45° FOV
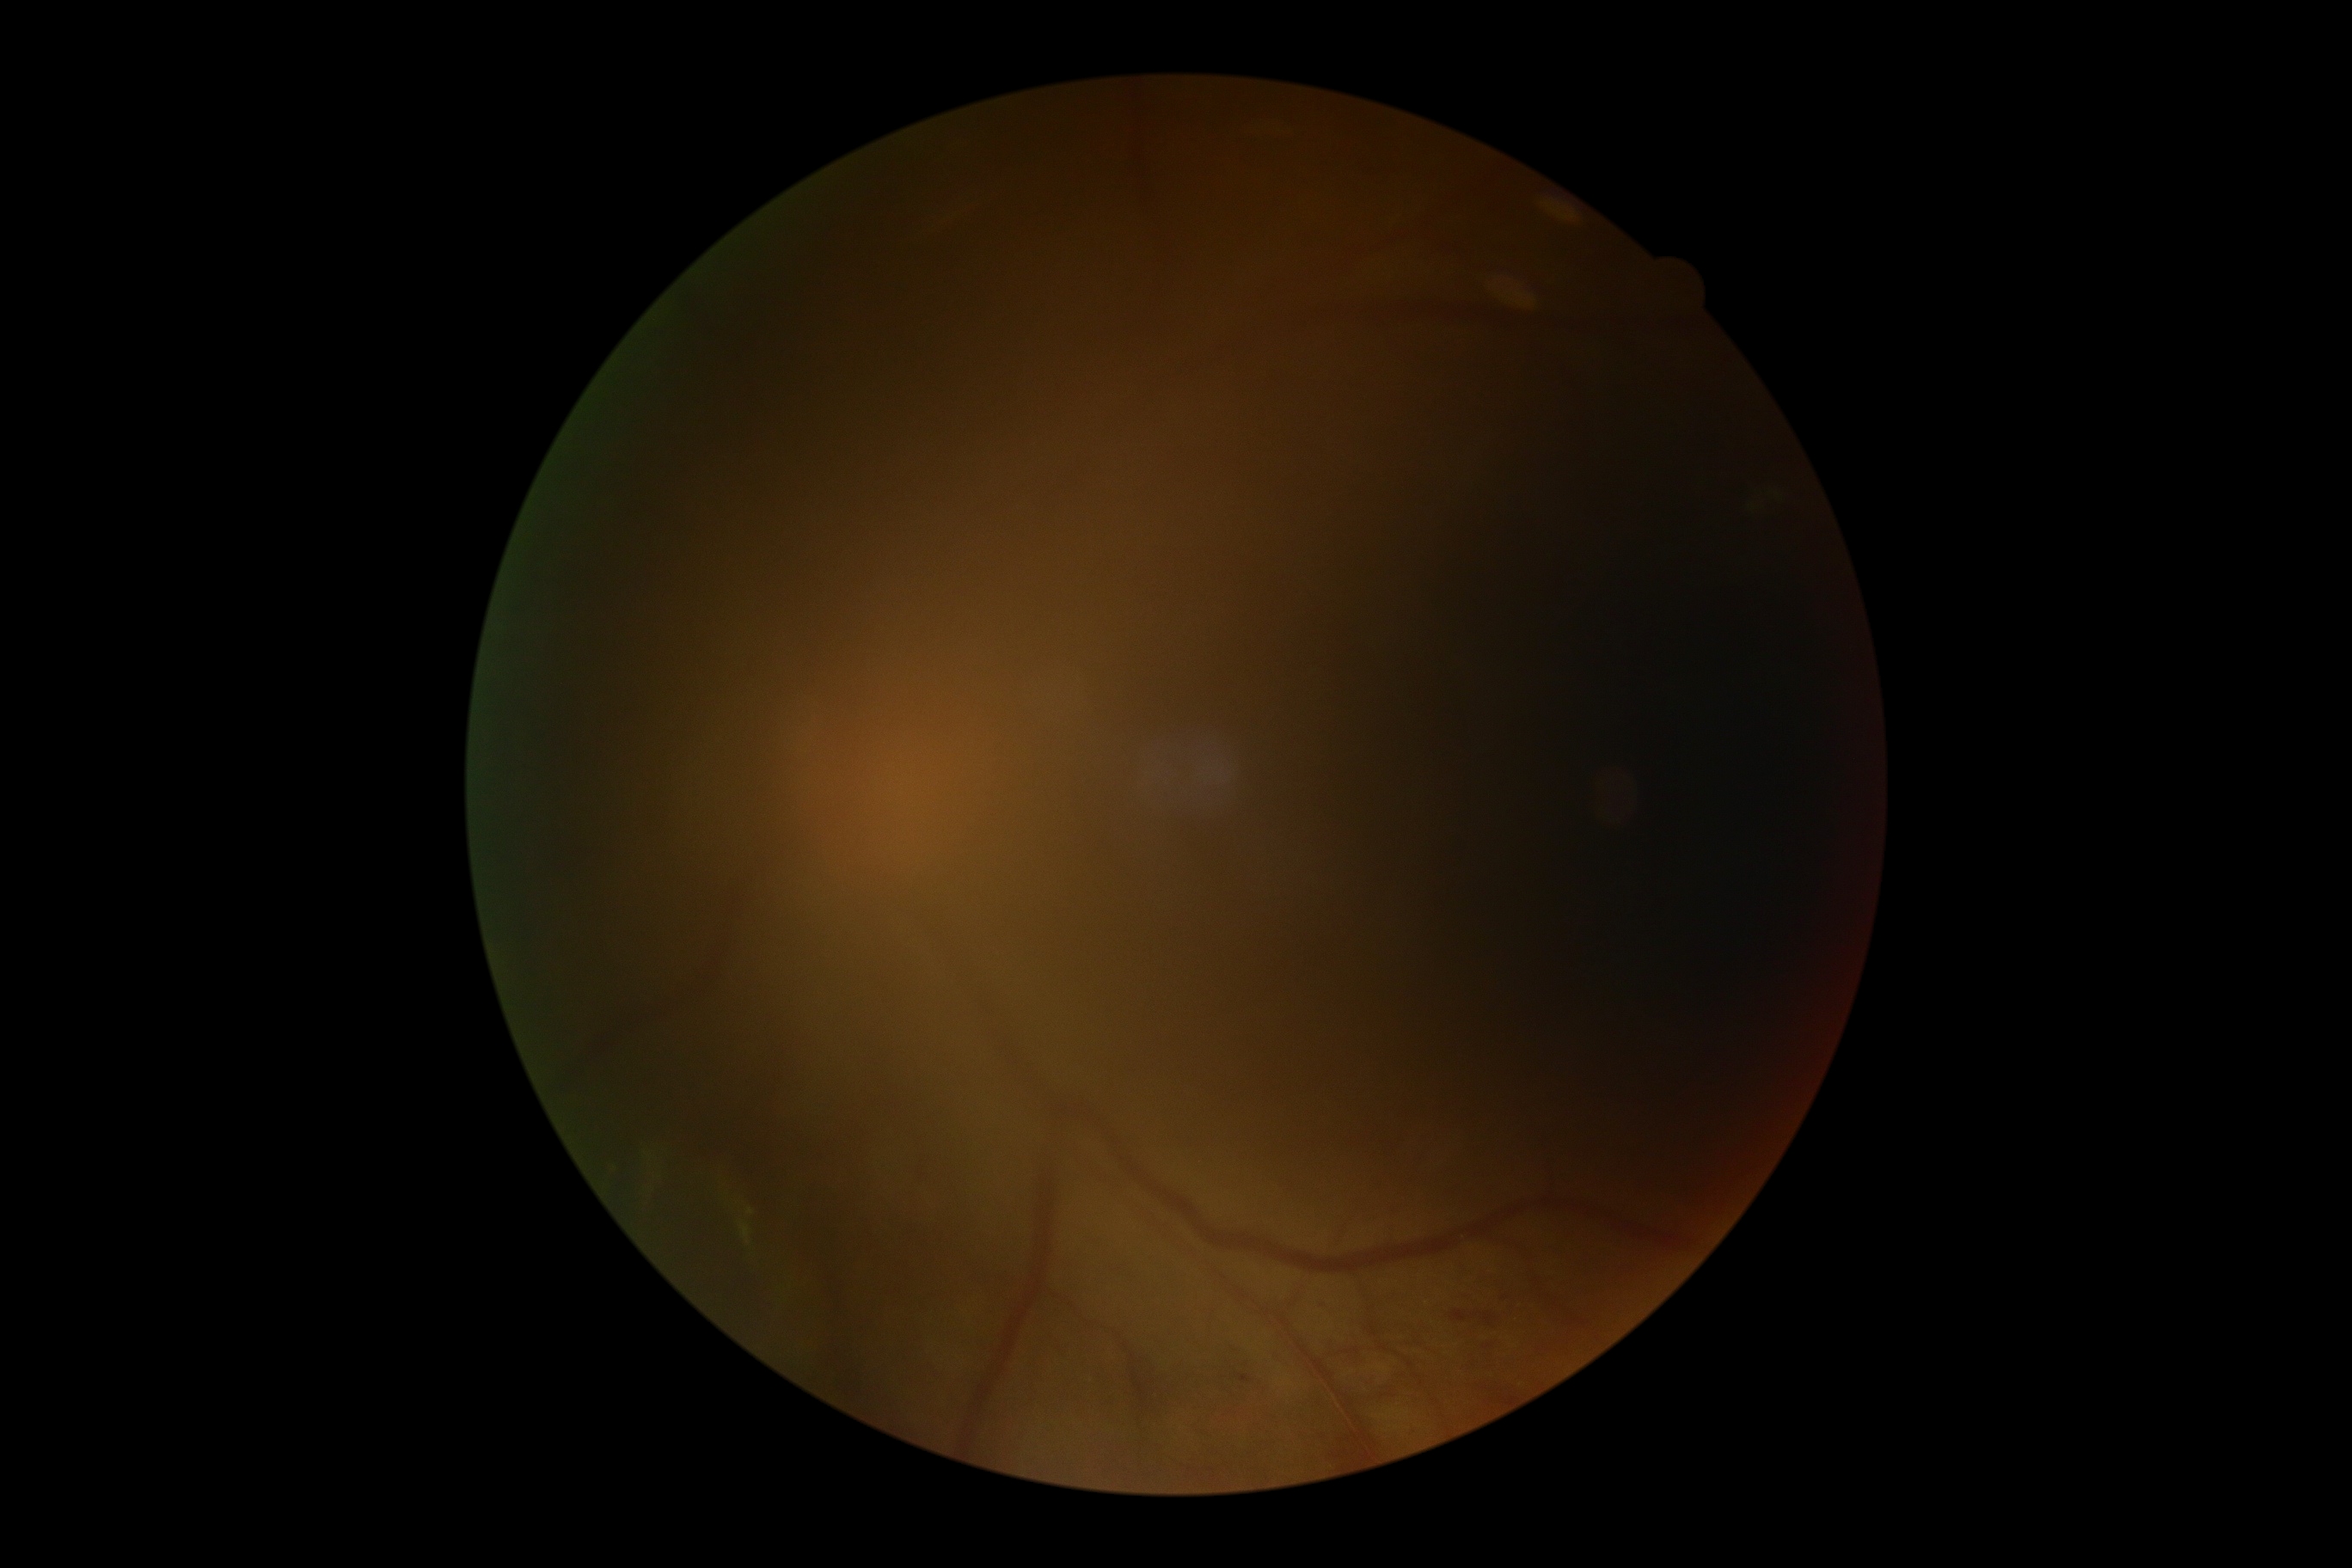 DR stage is 2/4.